2048x1536. 45° field of view:
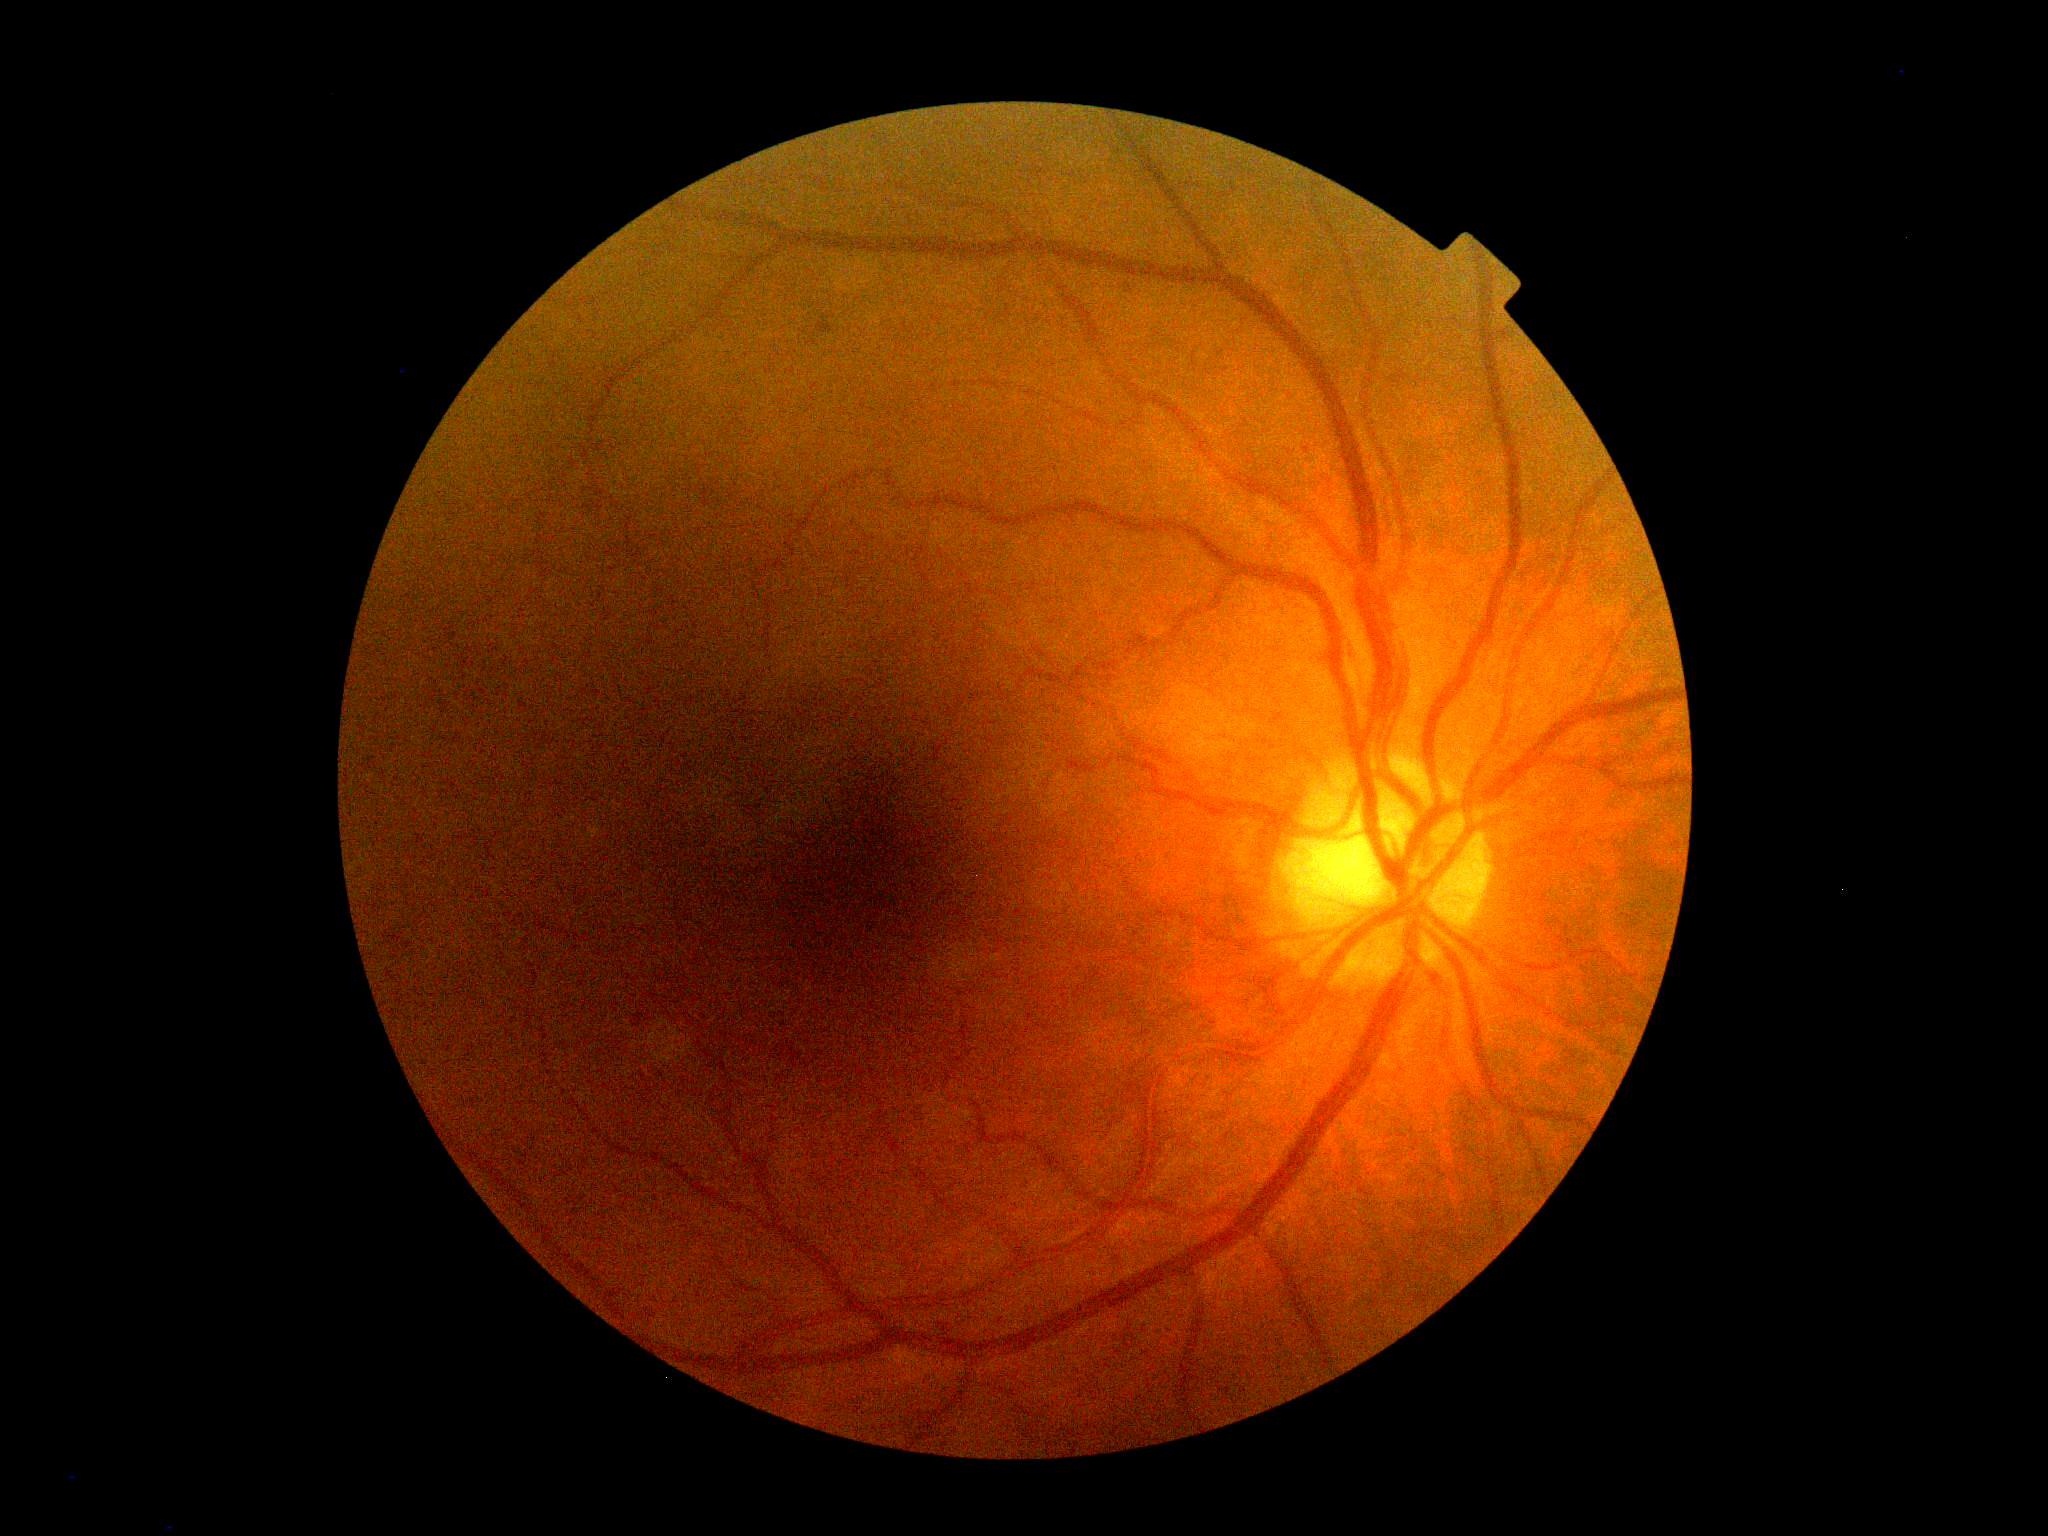
Diabetic retinopathy grade is mild NPDR (1).